Dilated-pupil acquisition: 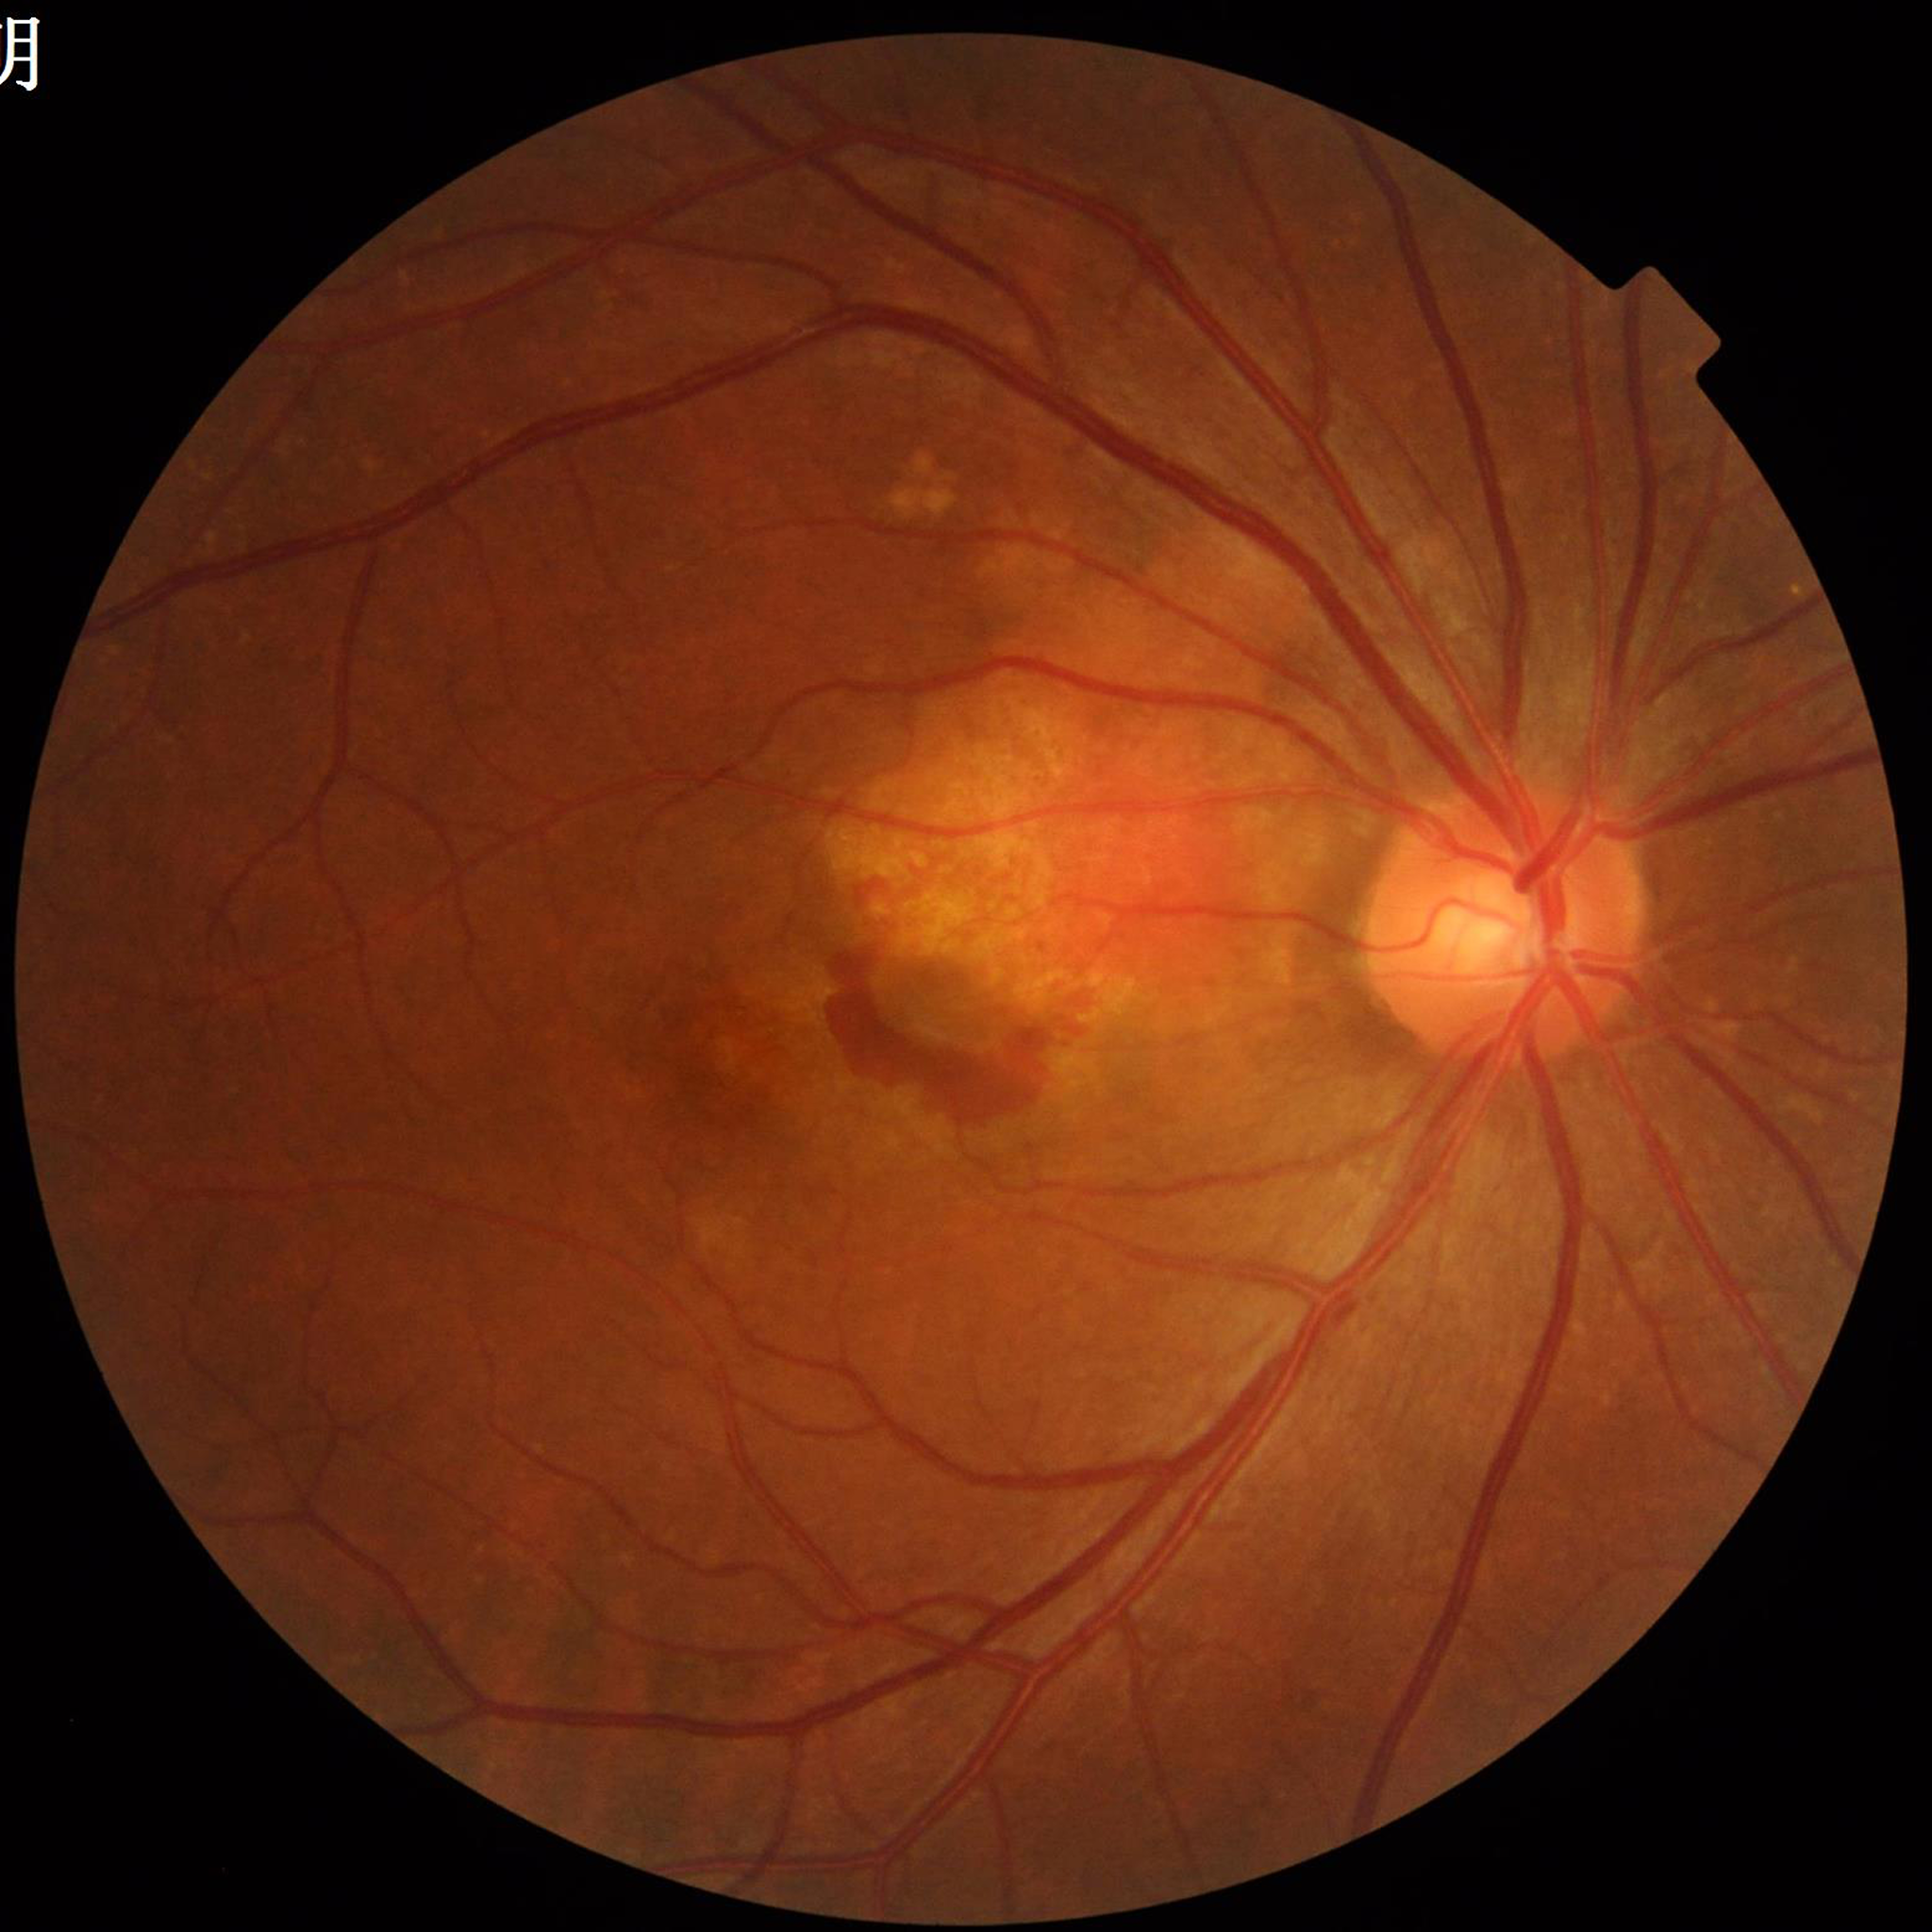
Condition = age-related macular degeneration